Optic disc region crop — 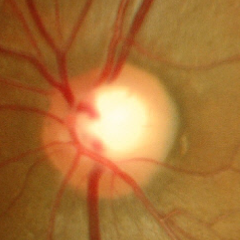

Q: Does this eye have glaucoma?
A: No — no glaucomatous optic neuropathy.